337x337, optic disc-centered crop from a color fundus photograph — 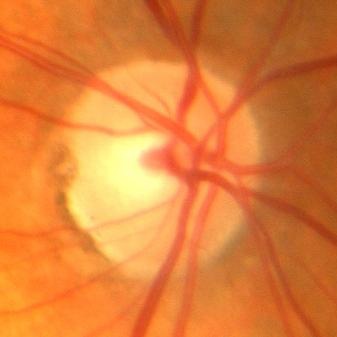

Demonstrates no glaucoma.